45° field of view, camera: NIDEK AFC-230, no pharmacologic dilation — 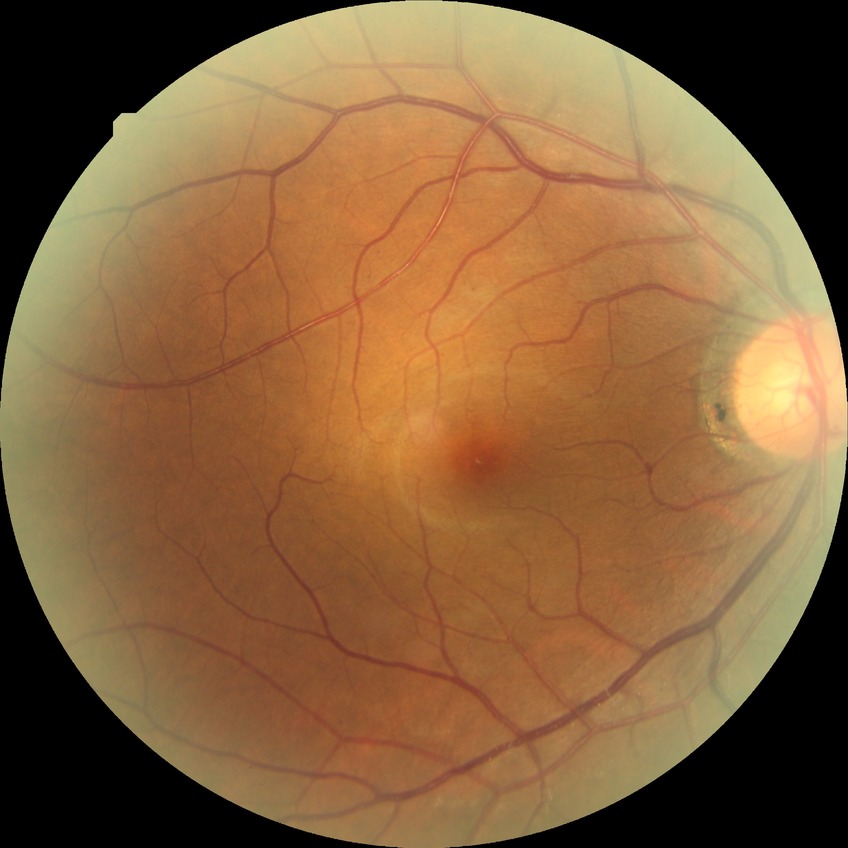

Disease class: non-proliferative diabetic retinopathy. Davis grade is SDR.